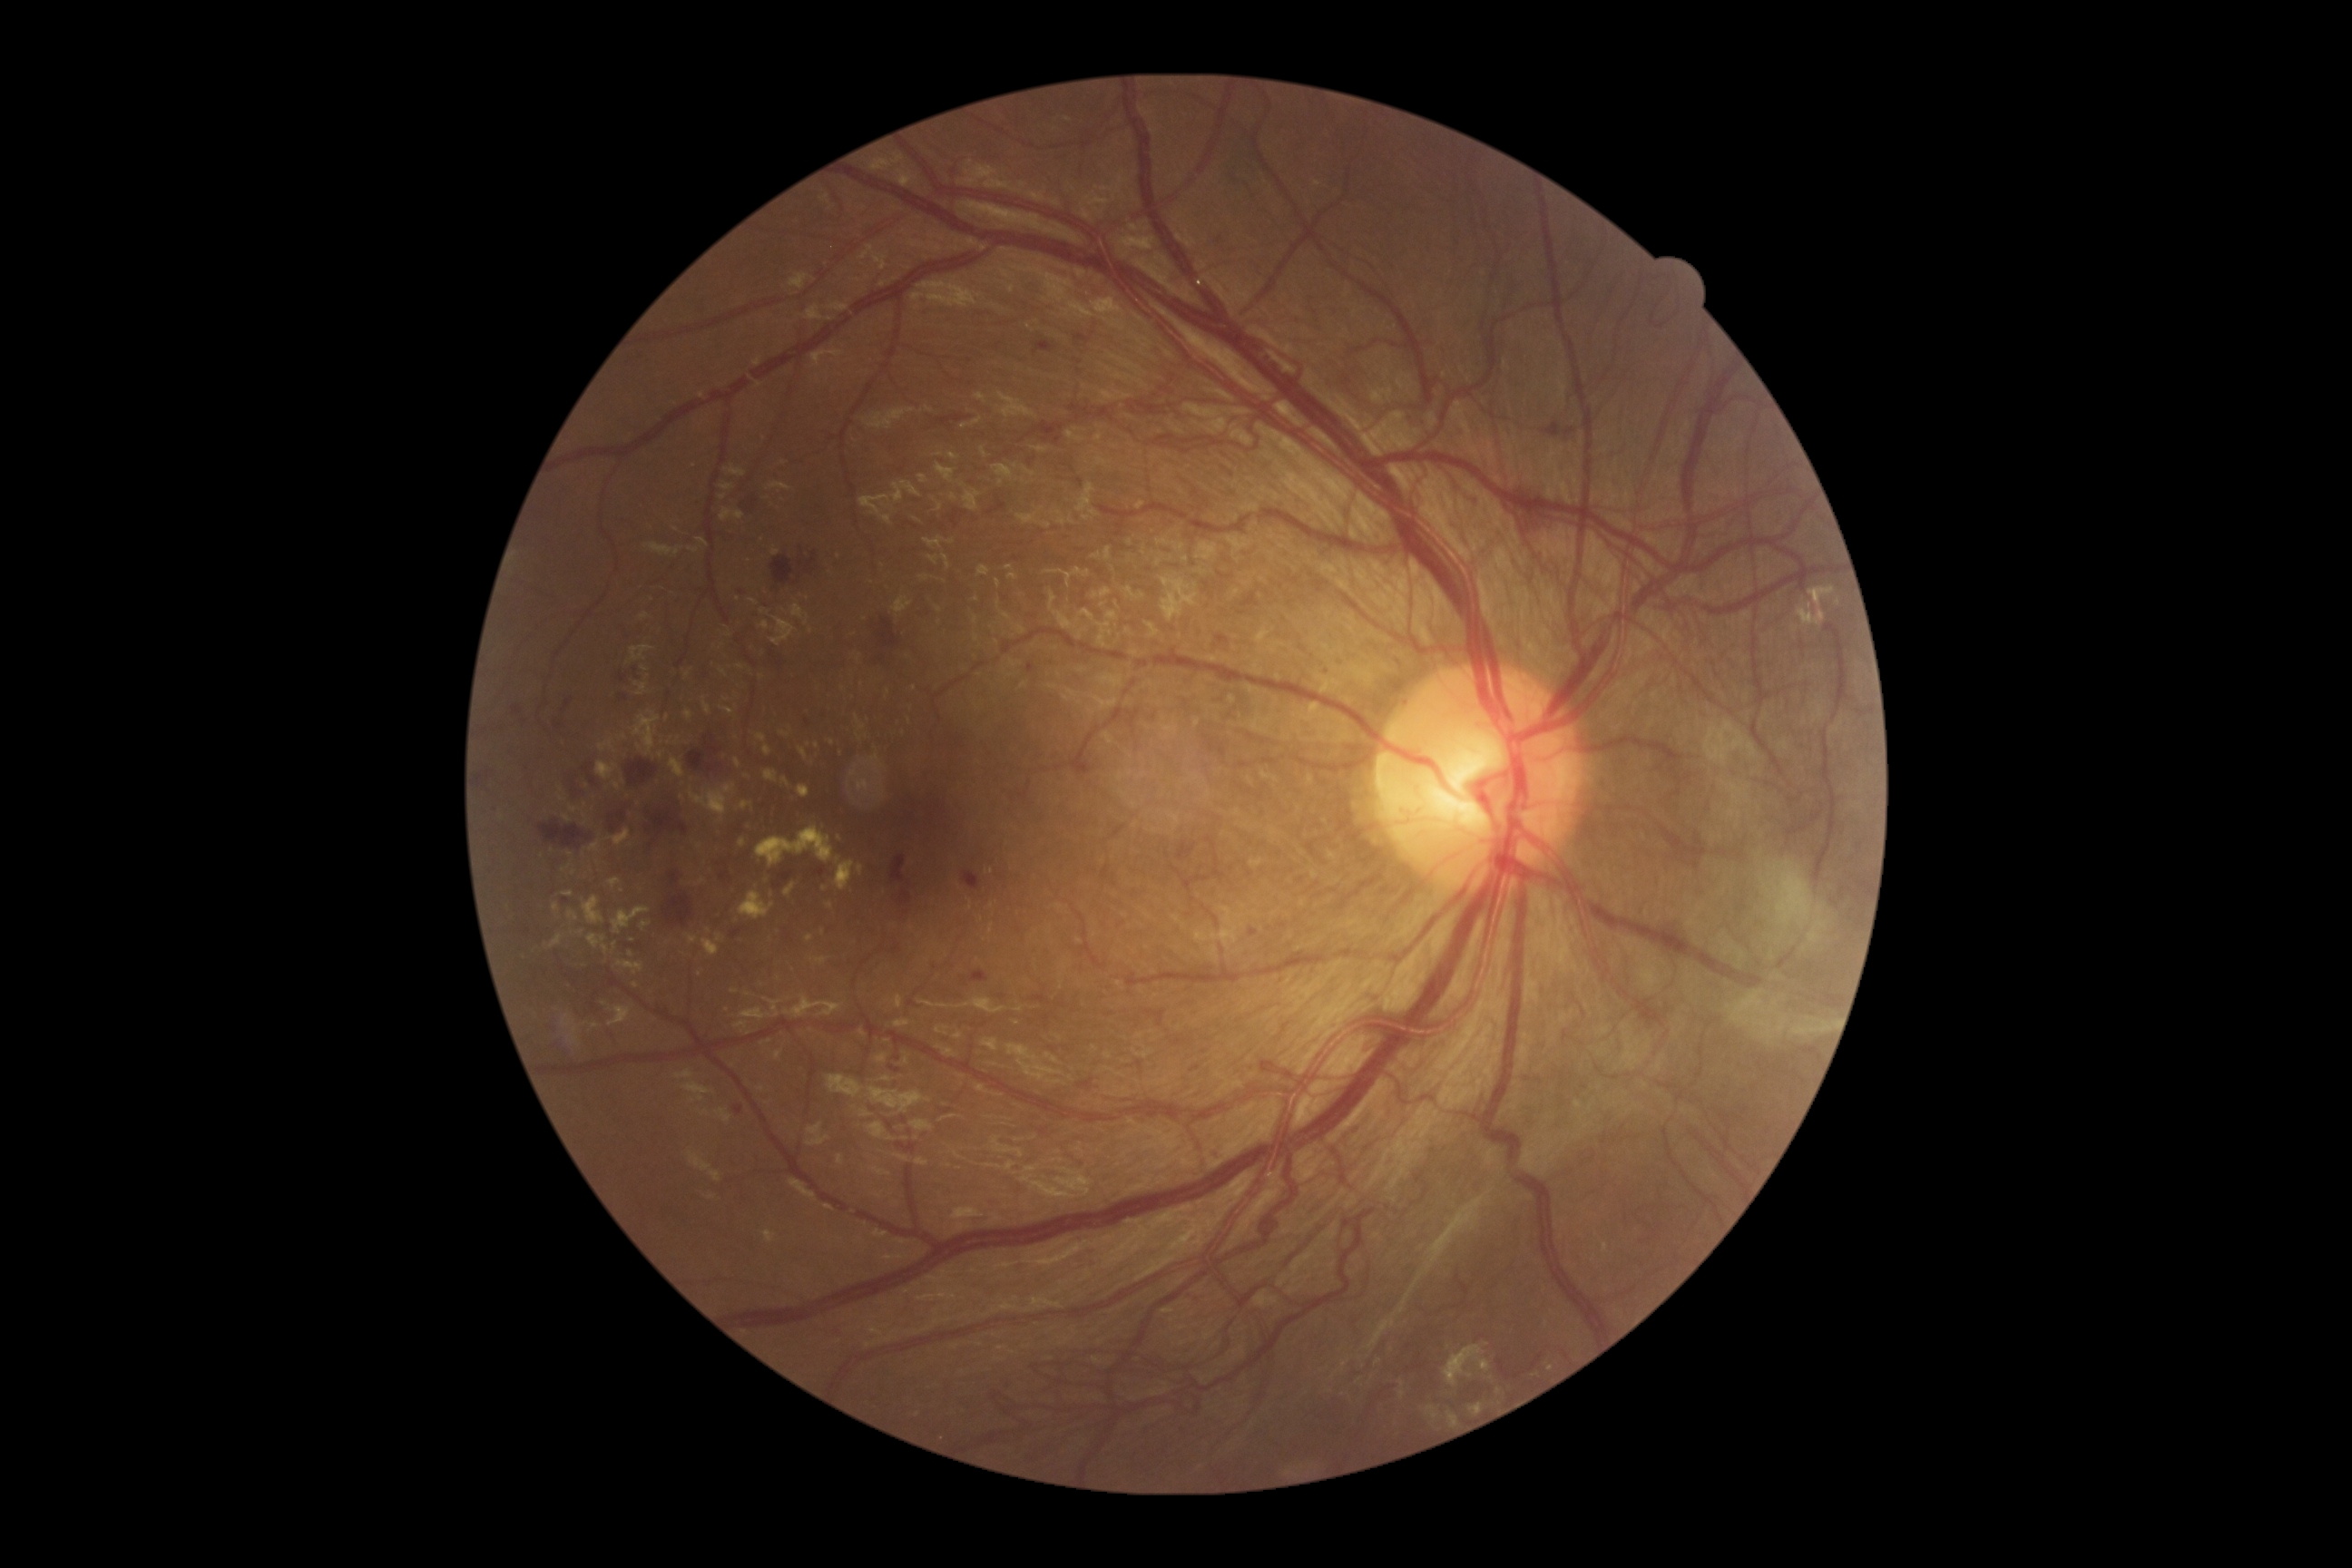
Retinopathy grade is PDR (4)
Lesions identified (partial list):
hard exudates (subset): (769, 484, 792, 491) | (609, 1006, 631, 1026) | (703, 698, 710, 714) | (785, 885, 796, 897) | (571, 807, 580, 814) | (614, 783, 622, 790) | (634, 710, 660, 756) | (894, 596, 912, 614) | (640, 614, 651, 622) | (685, 672, 691, 680) | (721, 484, 734, 491)
Hard exudates (small, approximate centers) near Point(681, 797) | Point(587, 823) | Point(709, 931) | Point(636, 985) | Point(817, 746) | Point(1550, 1368) | Point(865, 620)